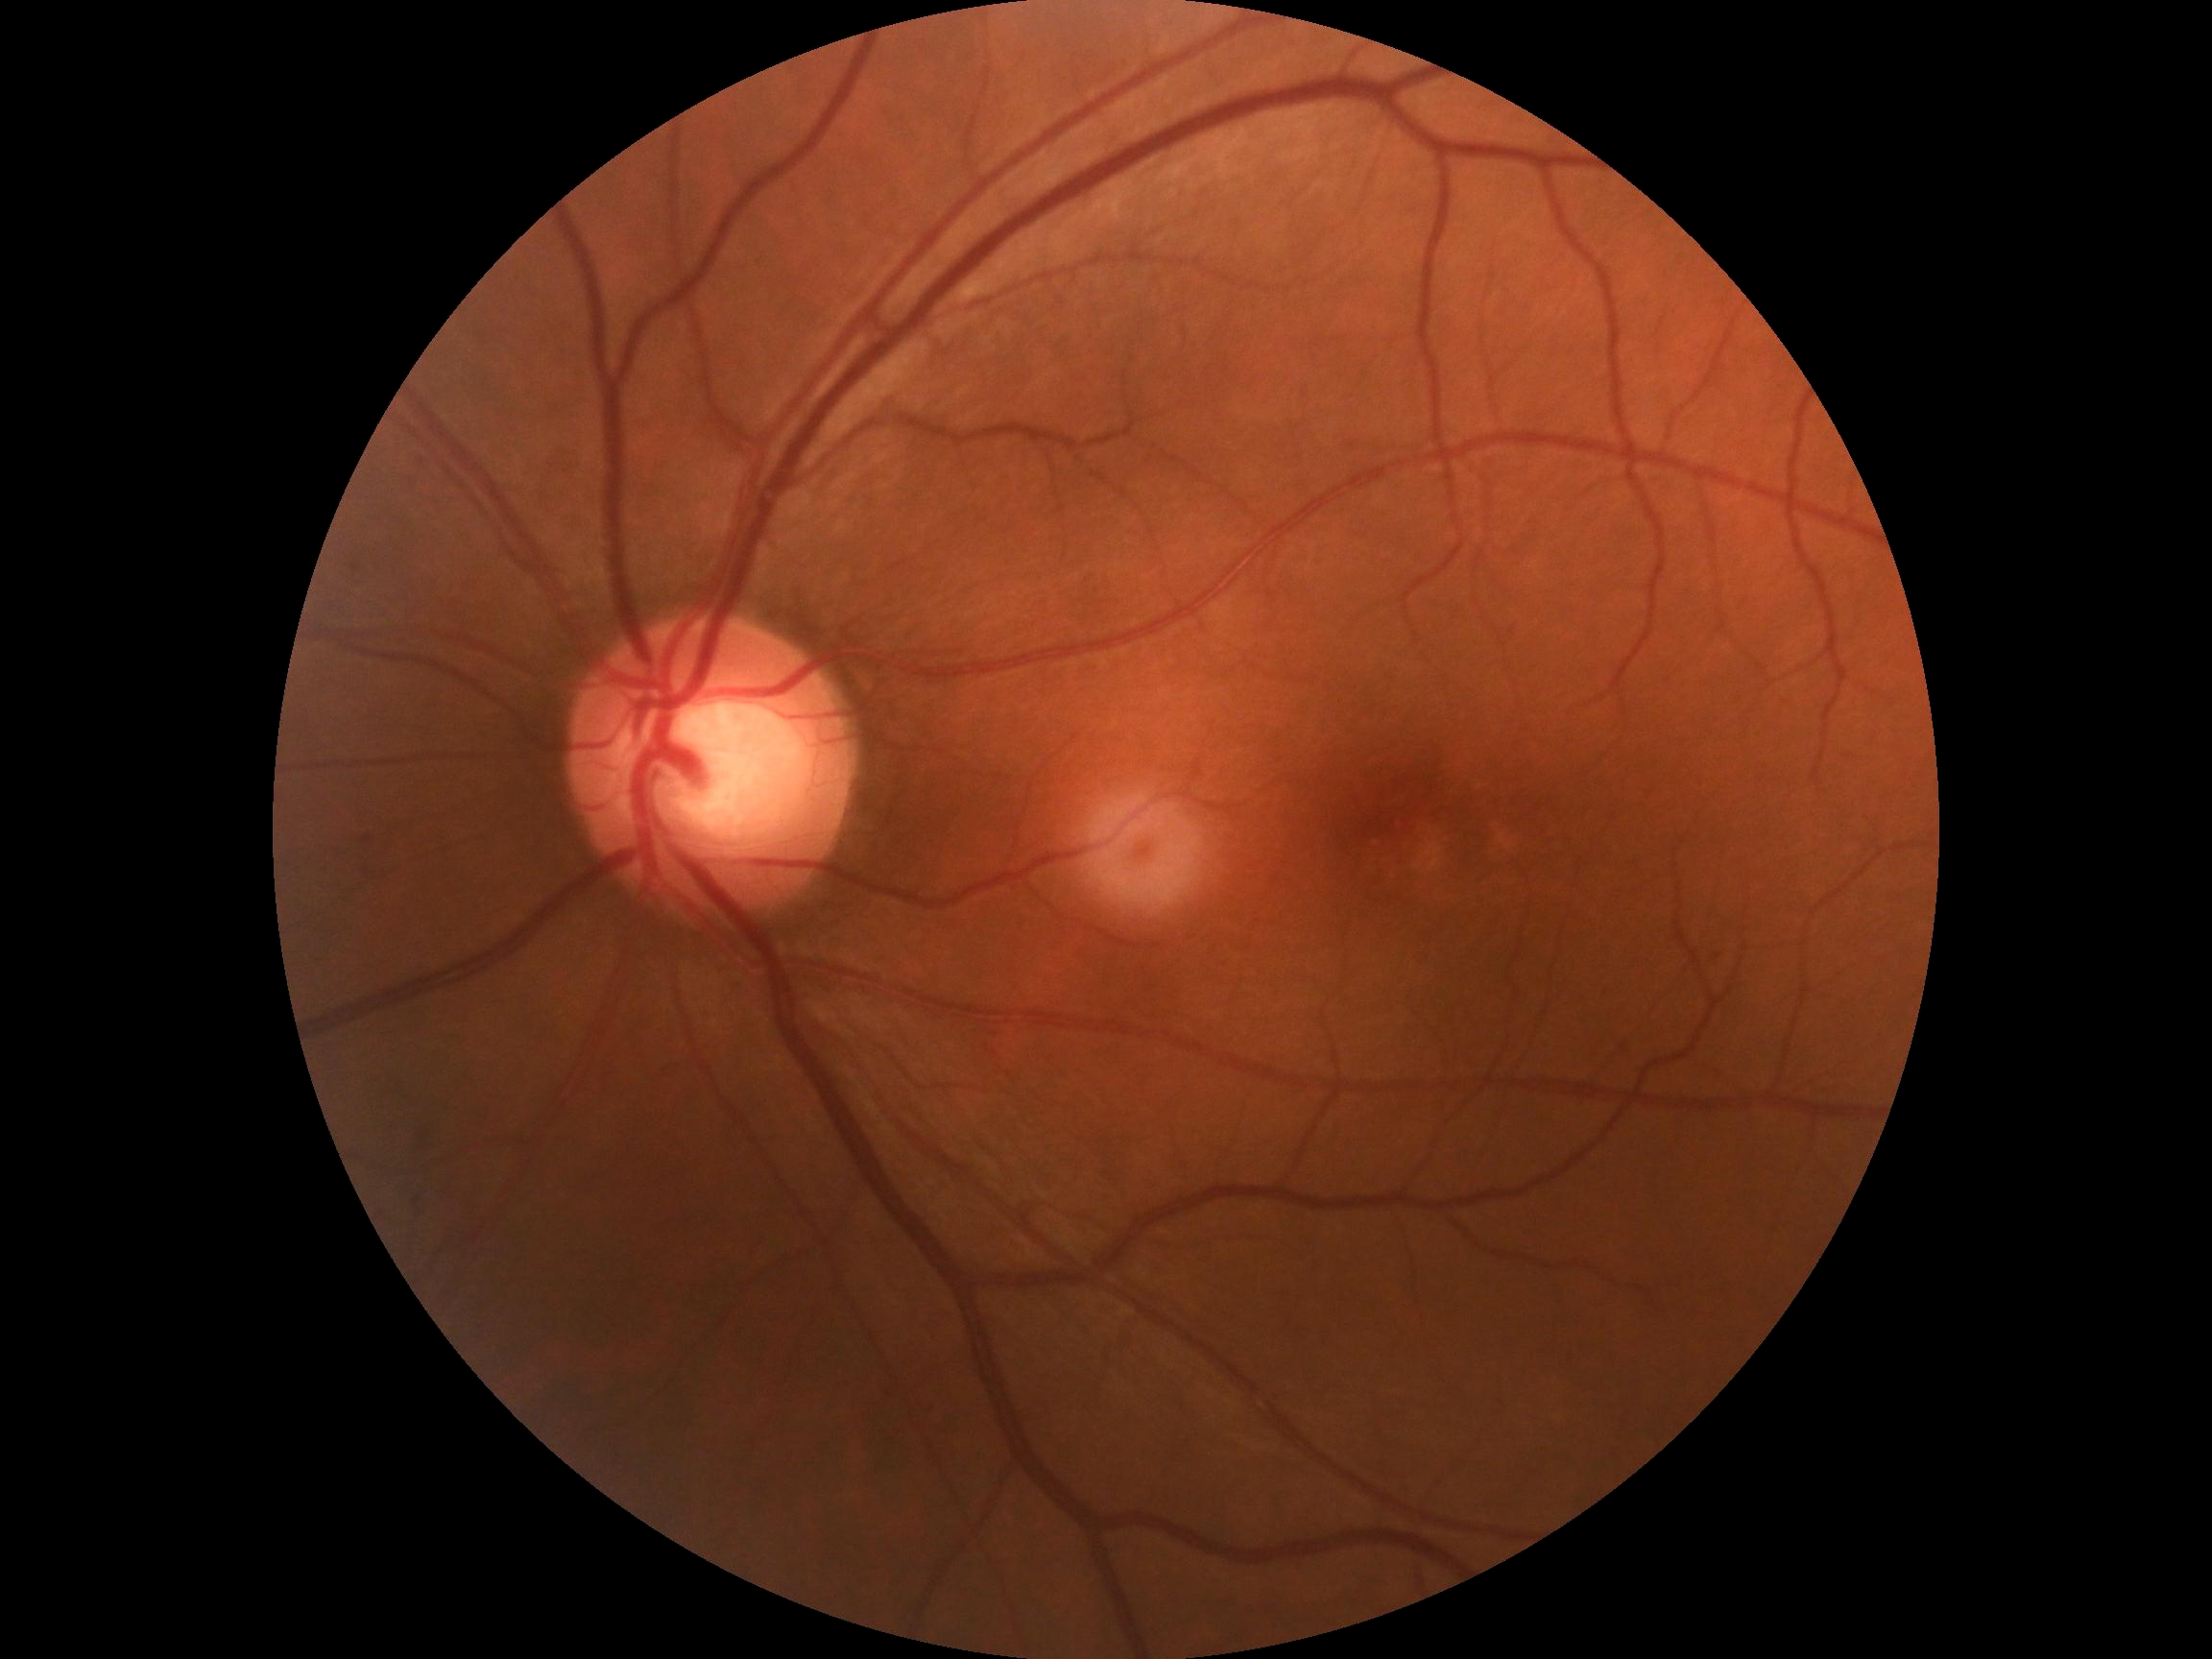   dr_grade: 2
  dr_category: non-proliferative diabetic retinopathy